Fundus photo · 1380x1382 — 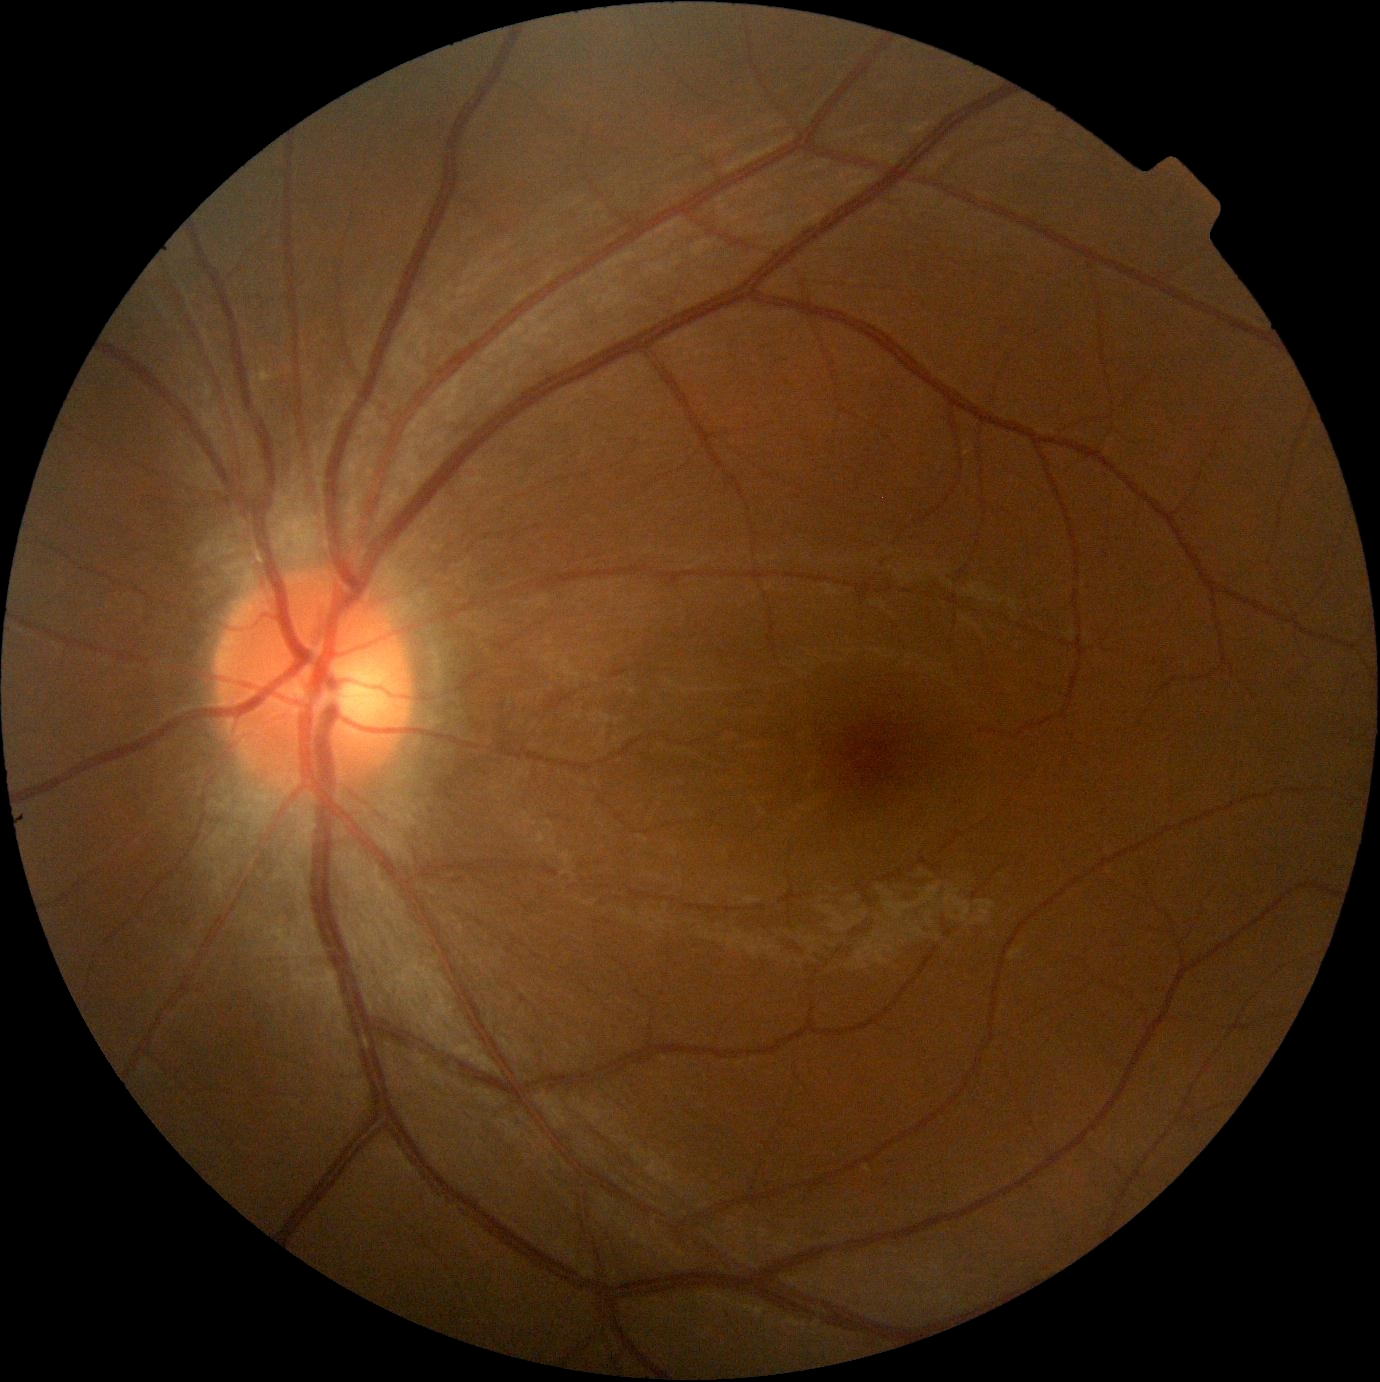
{
  "dr_grade": "grade 0 (no apparent retinopathy)"
}